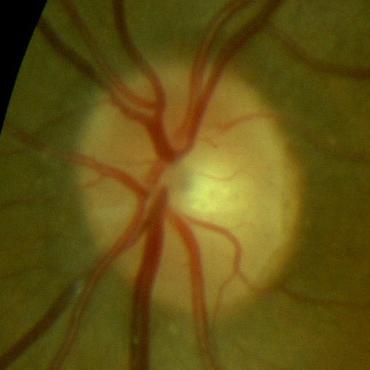

Consistent with no glaucomatous damage.